45-degree field of view · diabetic retinopathy graded by the modified Davis classification — 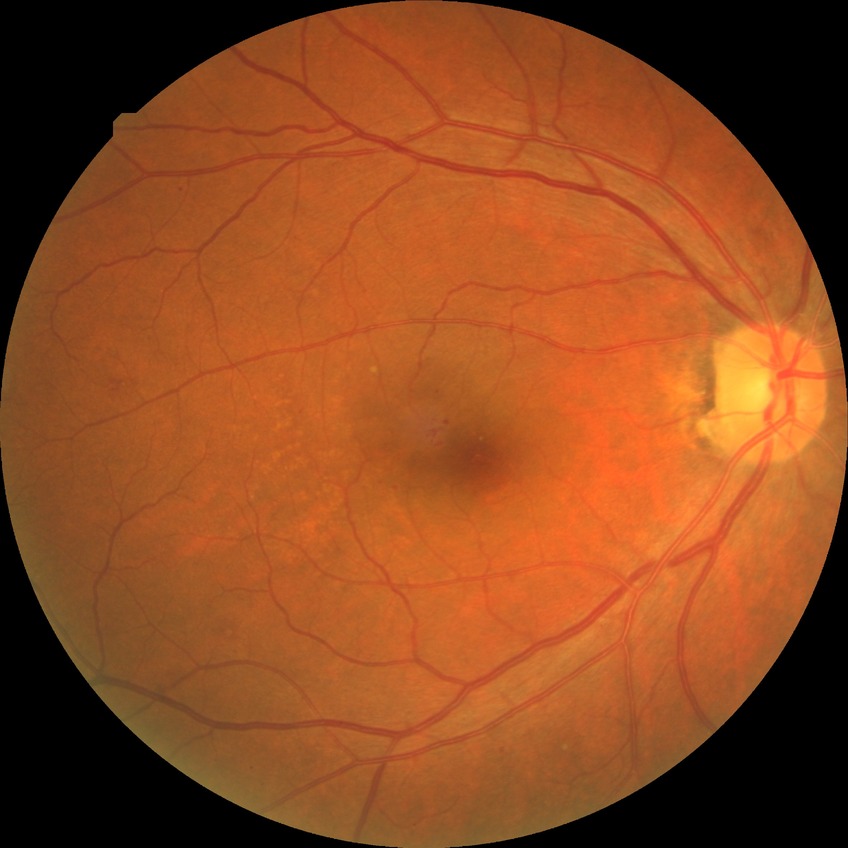 Retinopathy grade is simple diabetic retinopathy.